Optic disc region crop · acquired with a Nidek AFC-330 — 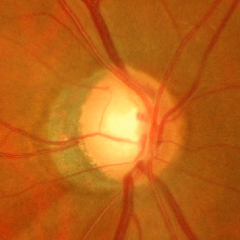
Optic disc photograph demonstrating severe glaucomatous damage. Defined as near-total cupping of the optic nerve head, with or without severe visual field loss within the central 10 degrees of fixation.